Without pupil dilation — 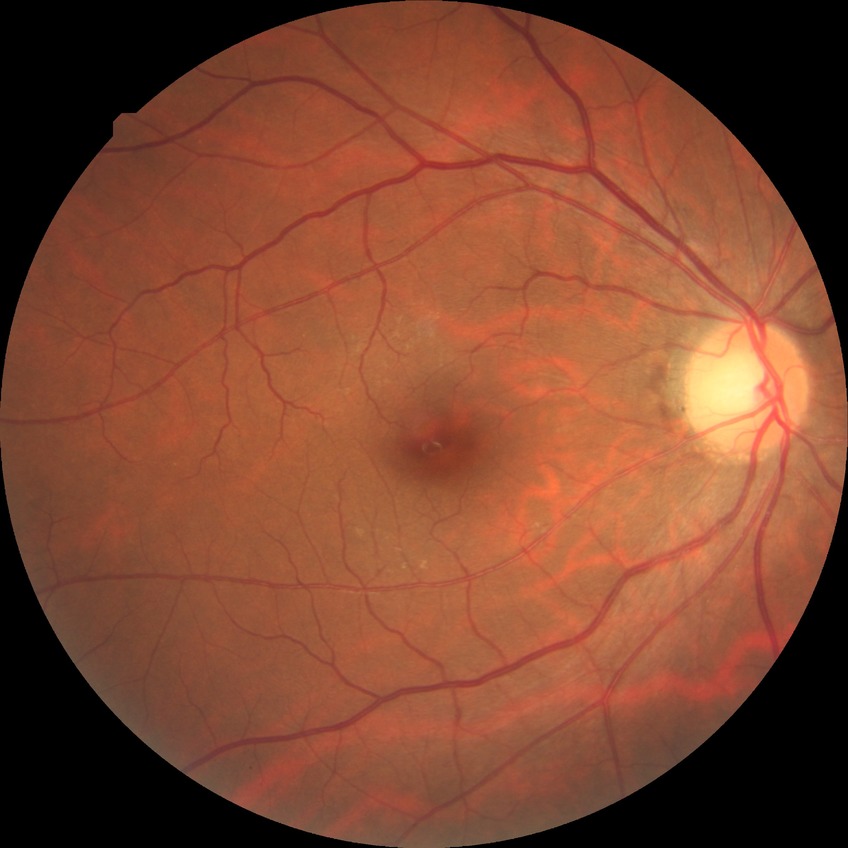 Diabetic retinopathy (DR): no diabetic retinopathy (NDR).